Diabetic retinopathy graded by the modified Davis classification.
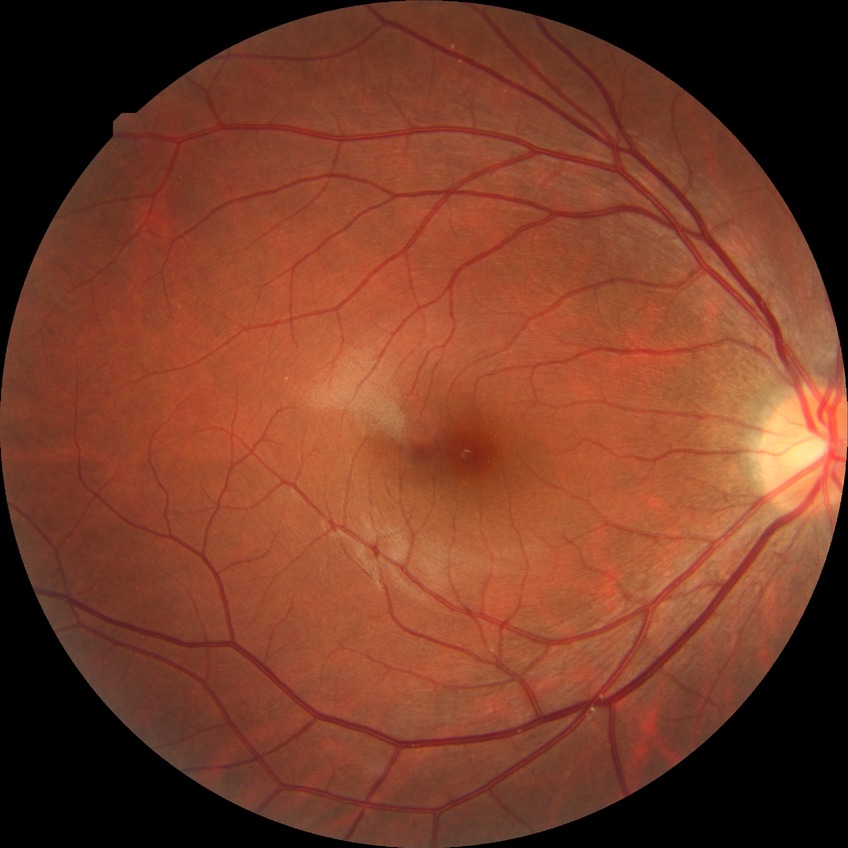

No DR findings. DR grade: NDR.